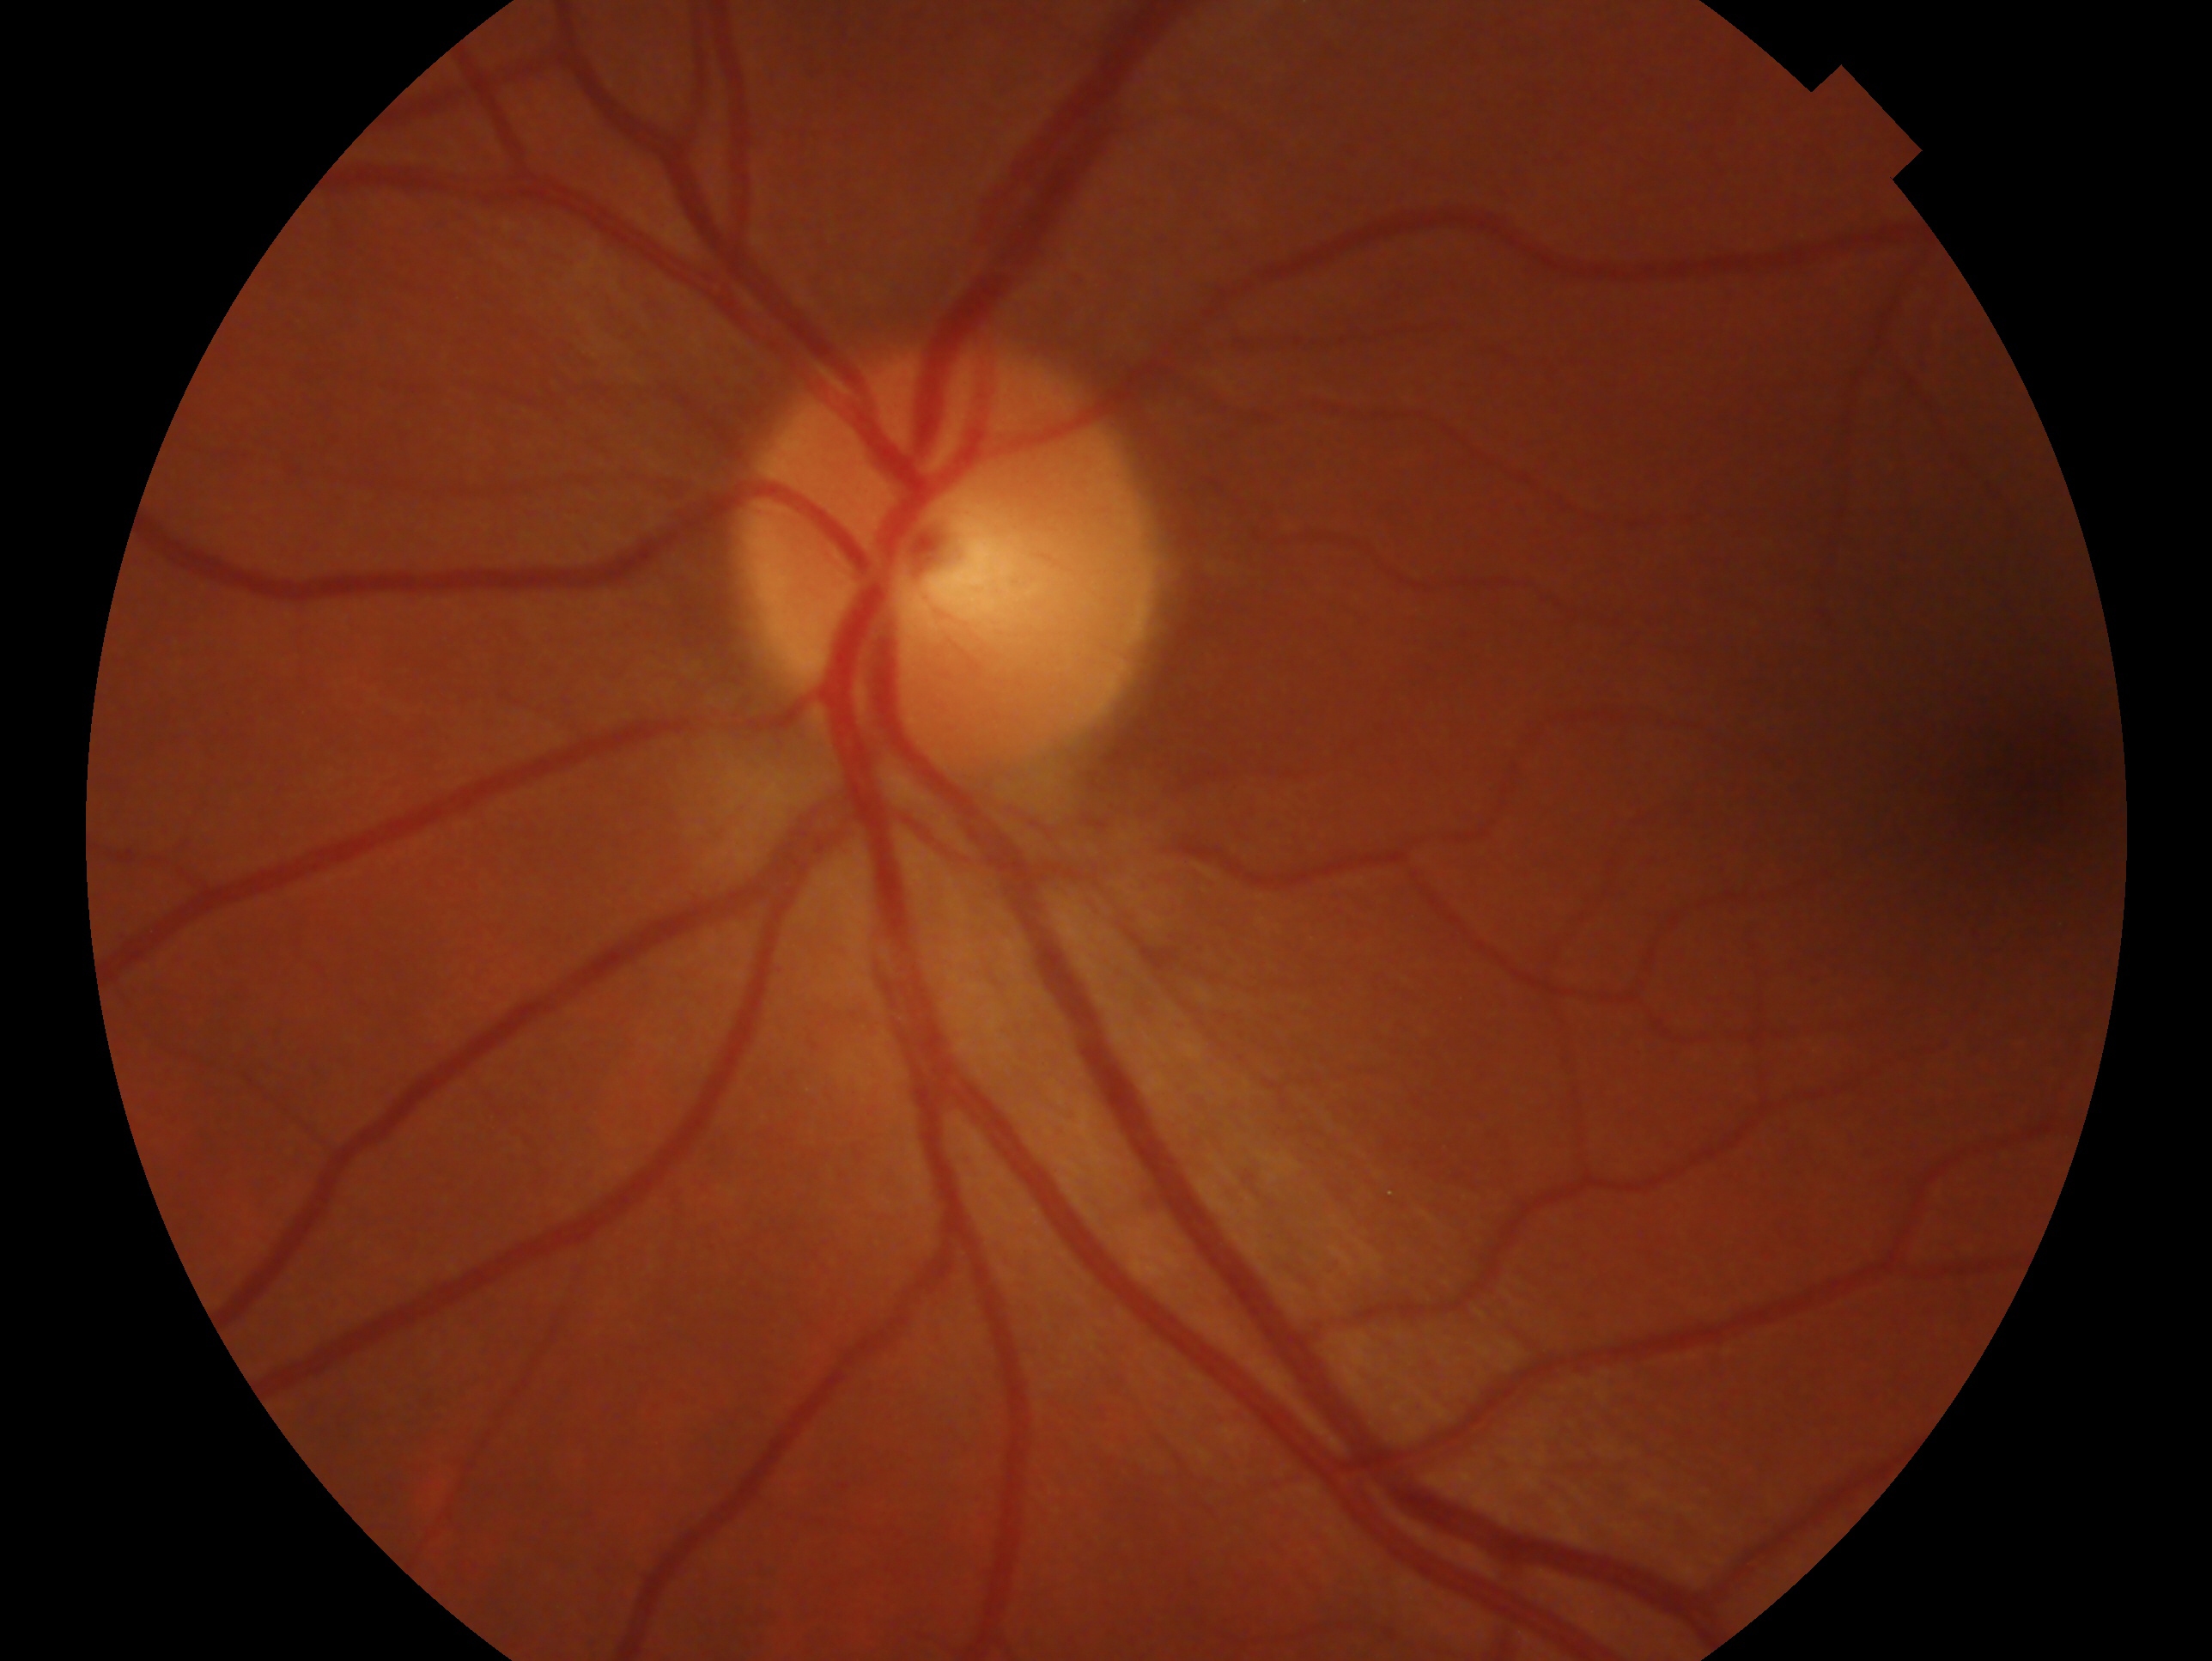

Assessment: no evidence of glaucoma. Imaged eye: oculus sinister.